FOV: 50 degrees
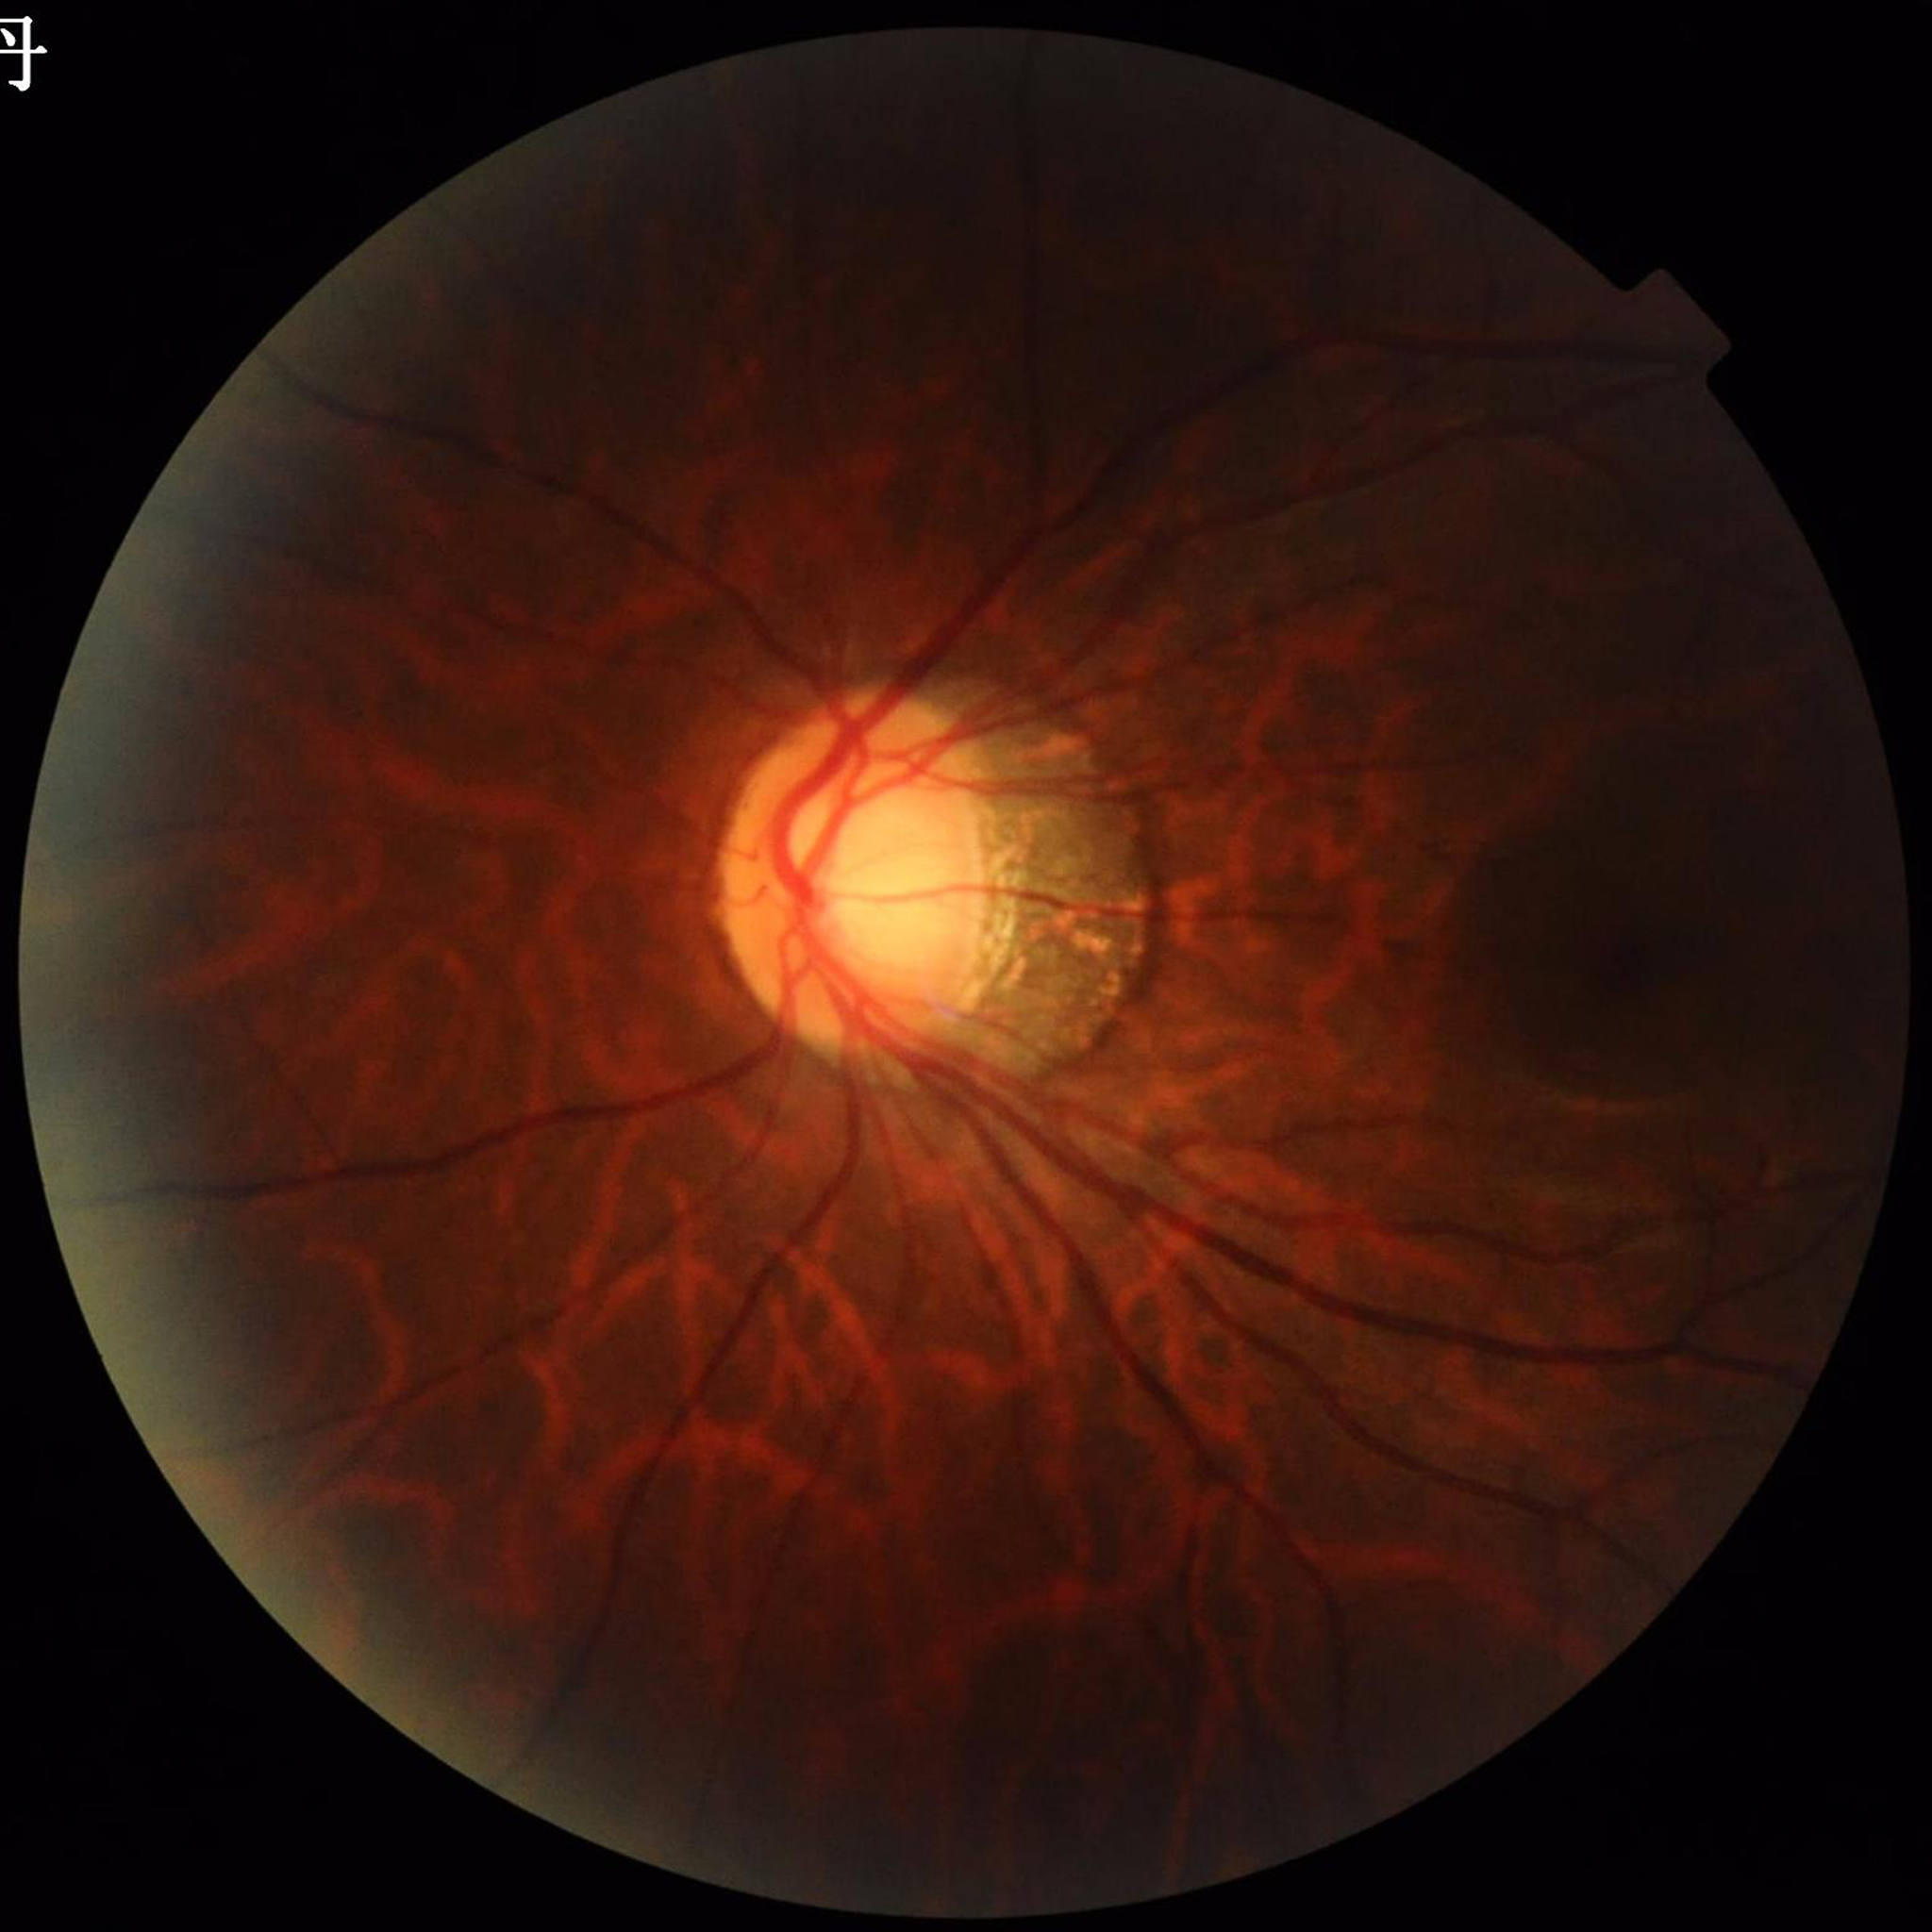
Photo quality: contrast adequate, no blur, illumination/color distortion present. Eye affected by glaucoma.